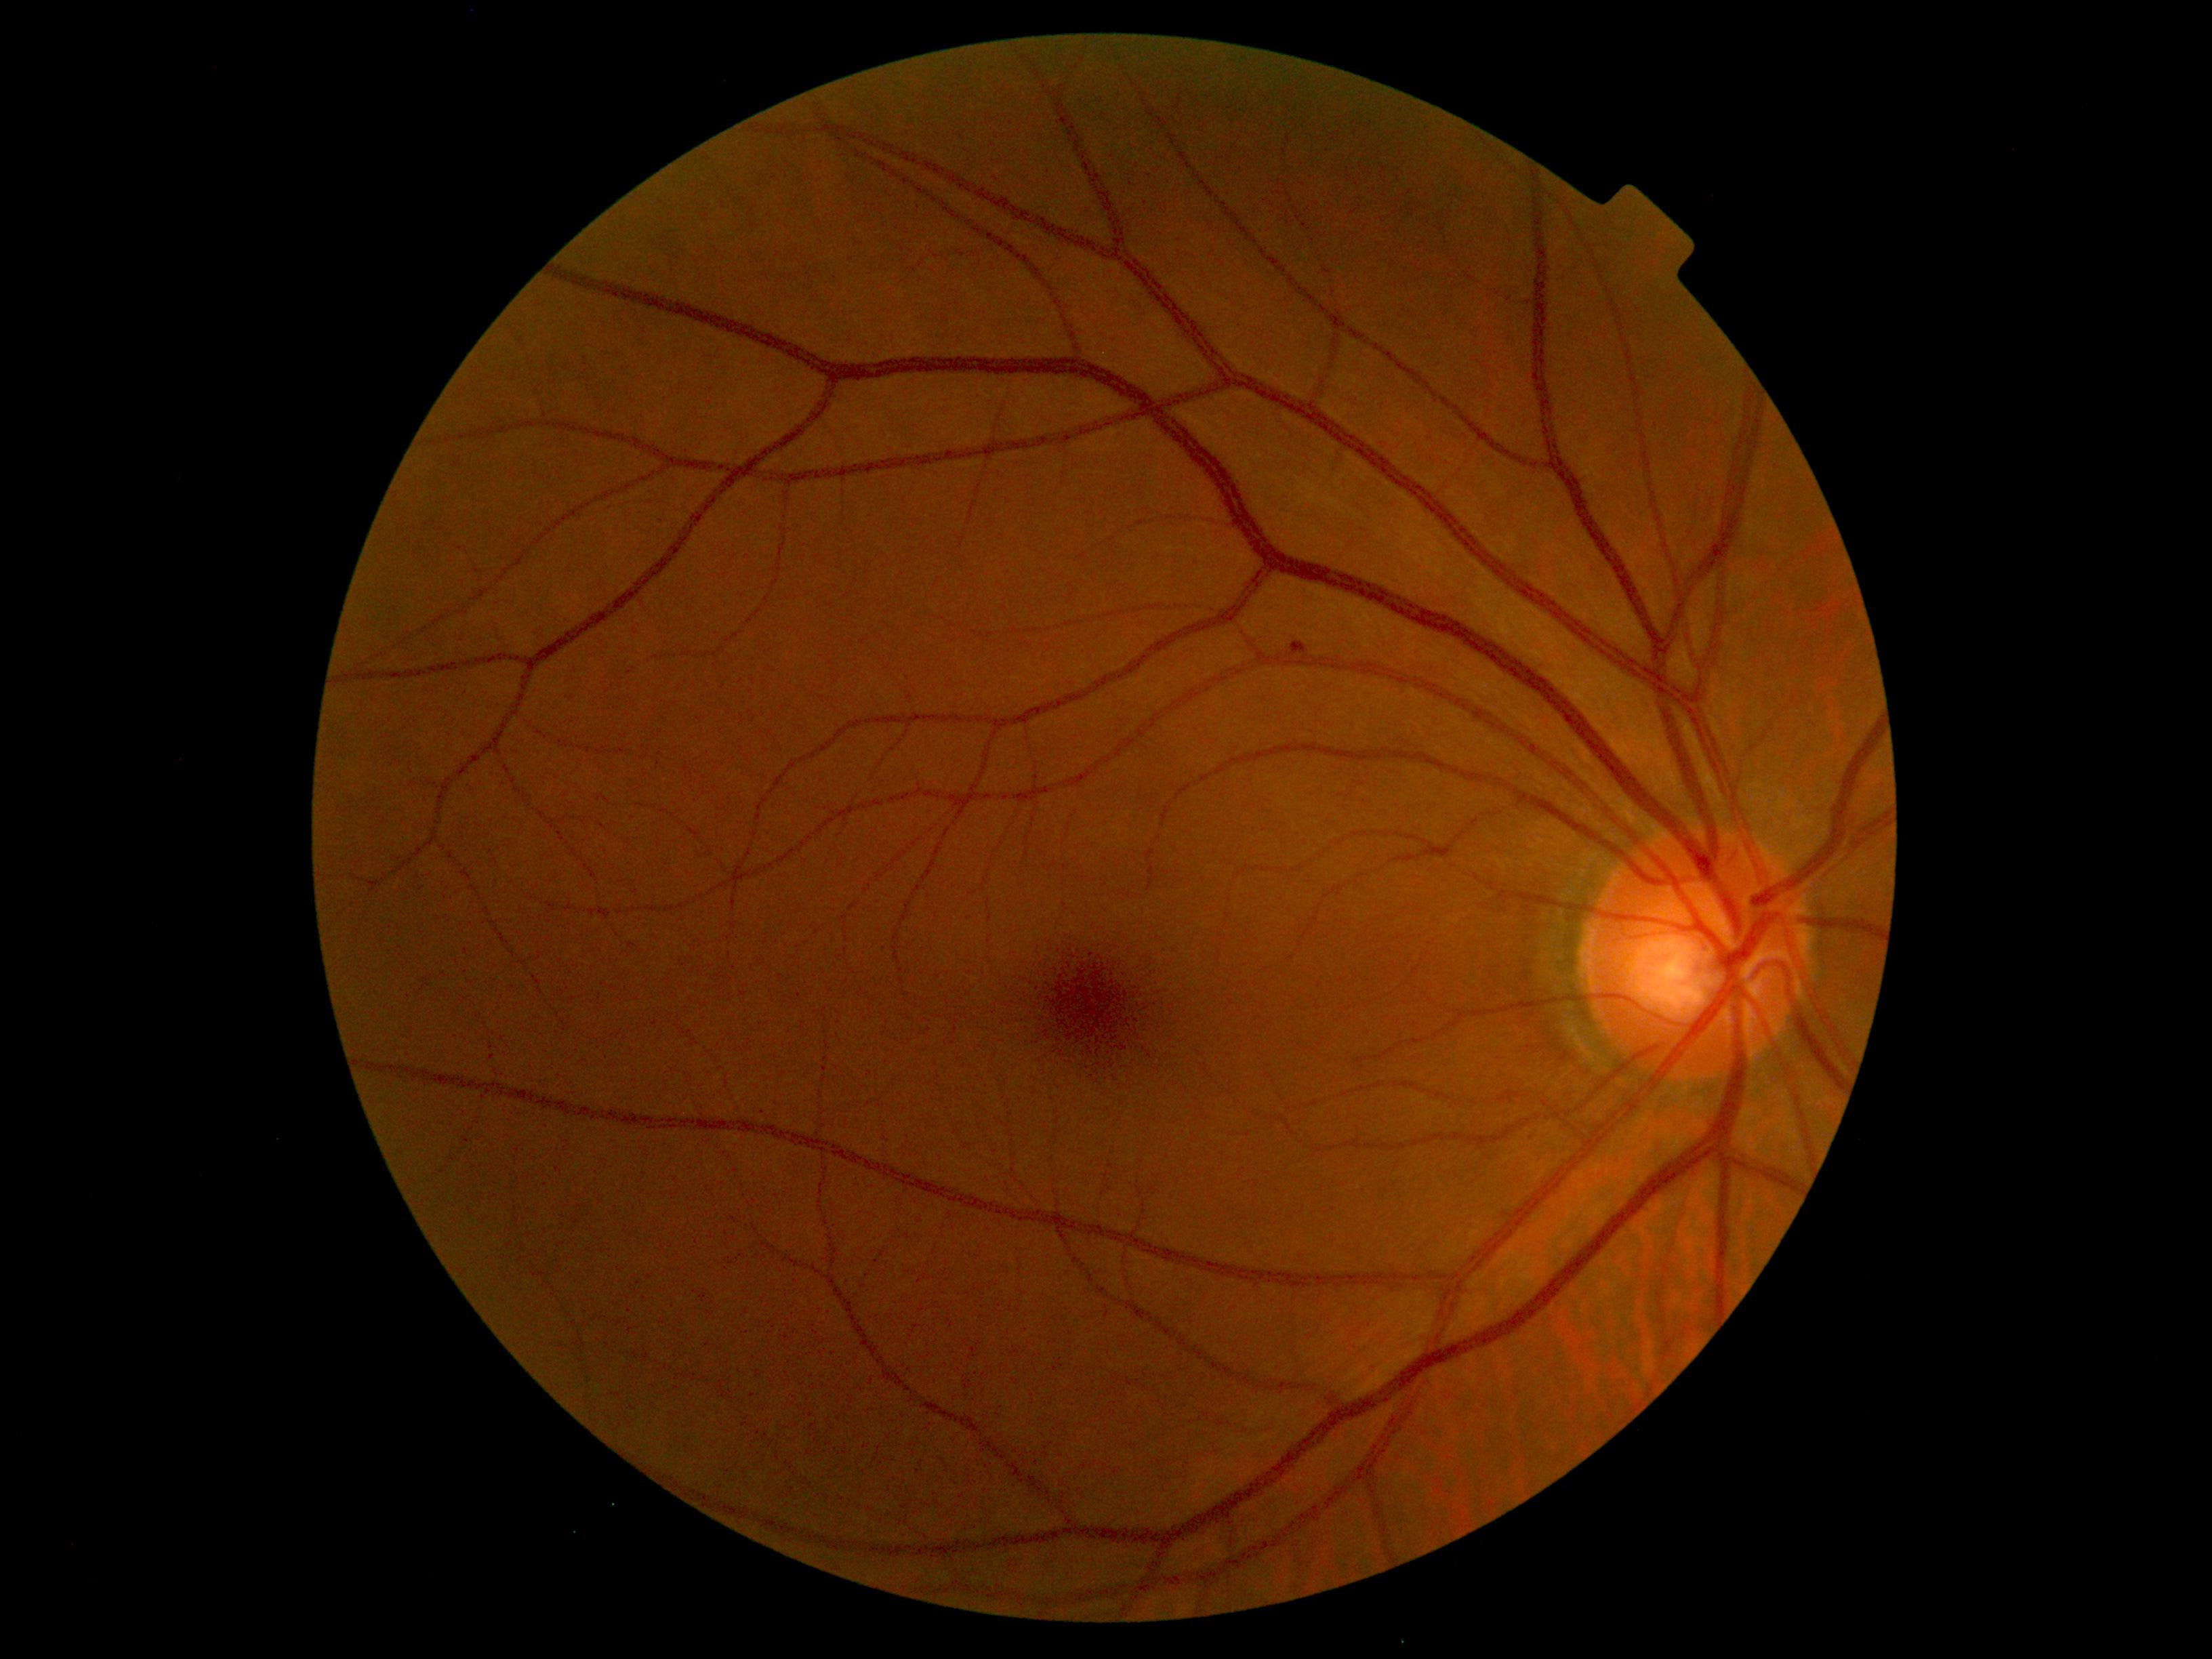
{"dr_grade": 1, "dr_grade_name": "mild NPDR", "lesions": {"he": null, "ex": null, "ma": [[1295, 644, 1309, 658]], "se": null}}